RetCam wide-field infant fundus image · 1440x1080px:
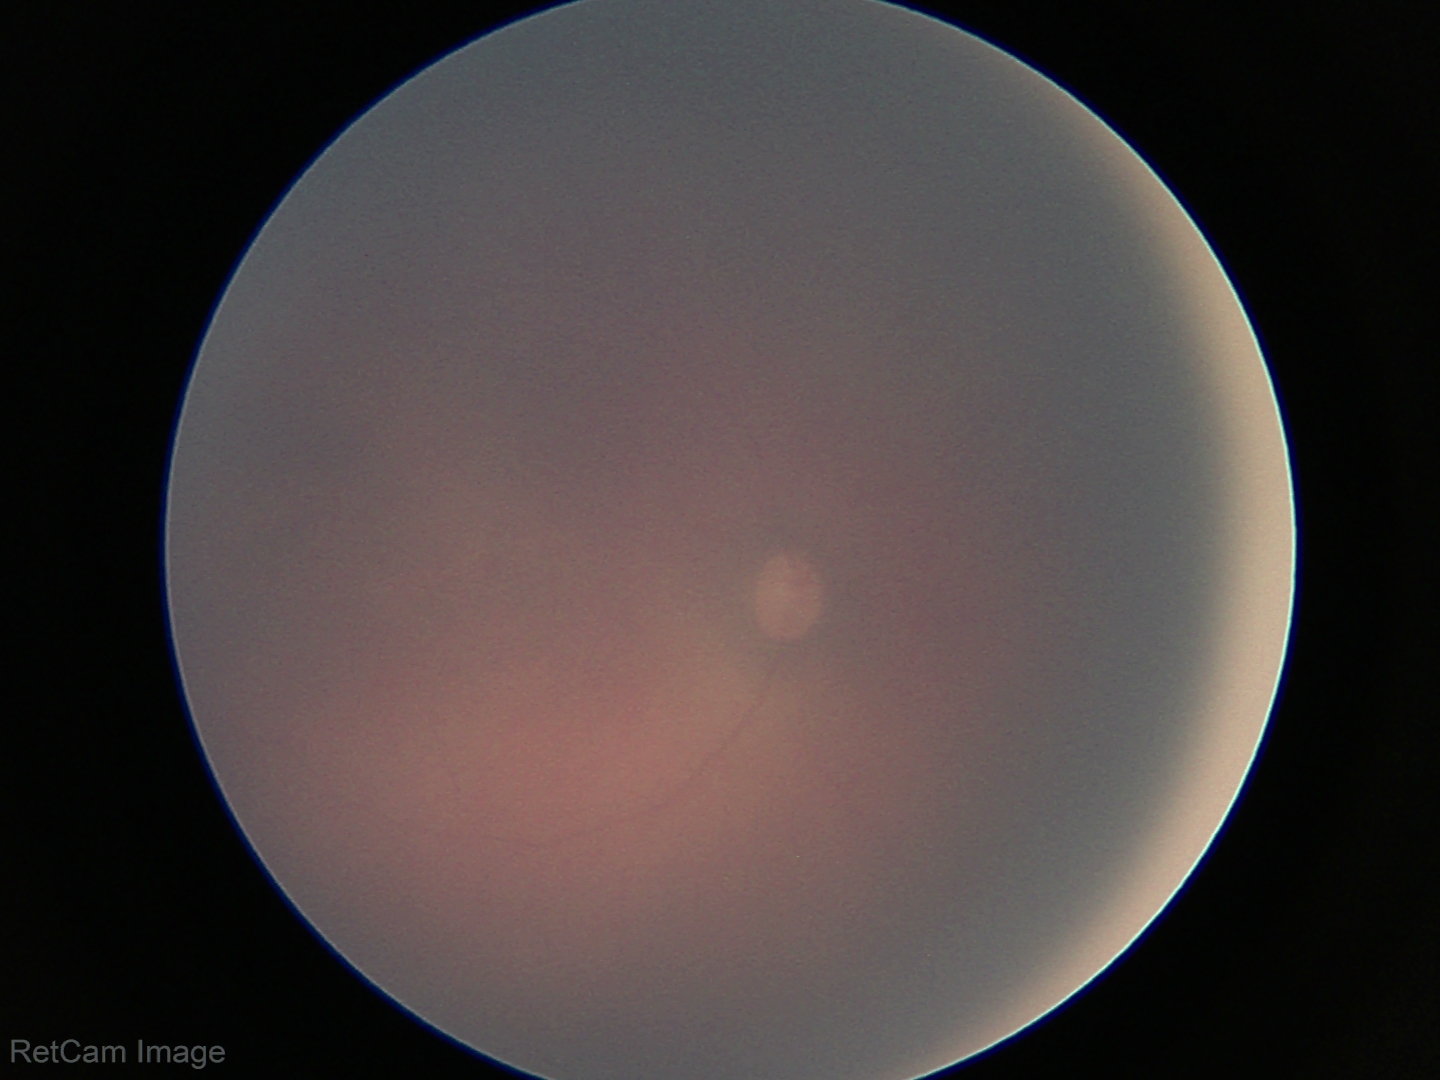 Physiological retinal appearance for postconceptual age.